848 x 848 pixels; color fundus image; modified Davis grading; NIDEK AFC-230 fundus camera:
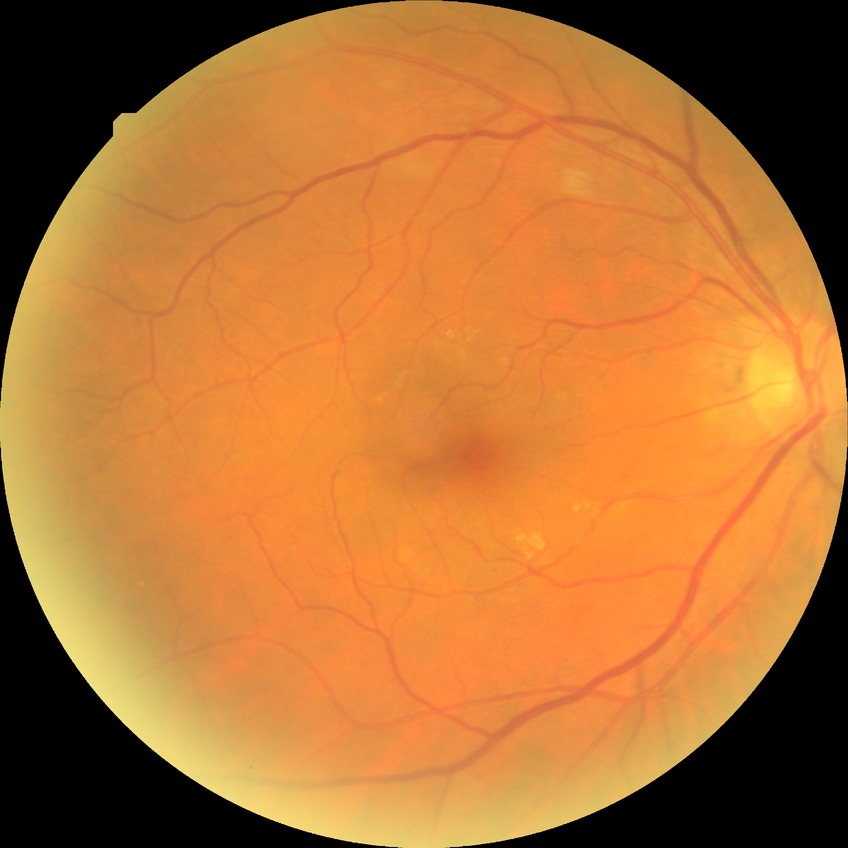 Modified Davis grading: no diabetic retinopathy.